CFP · image size 1534x1534: 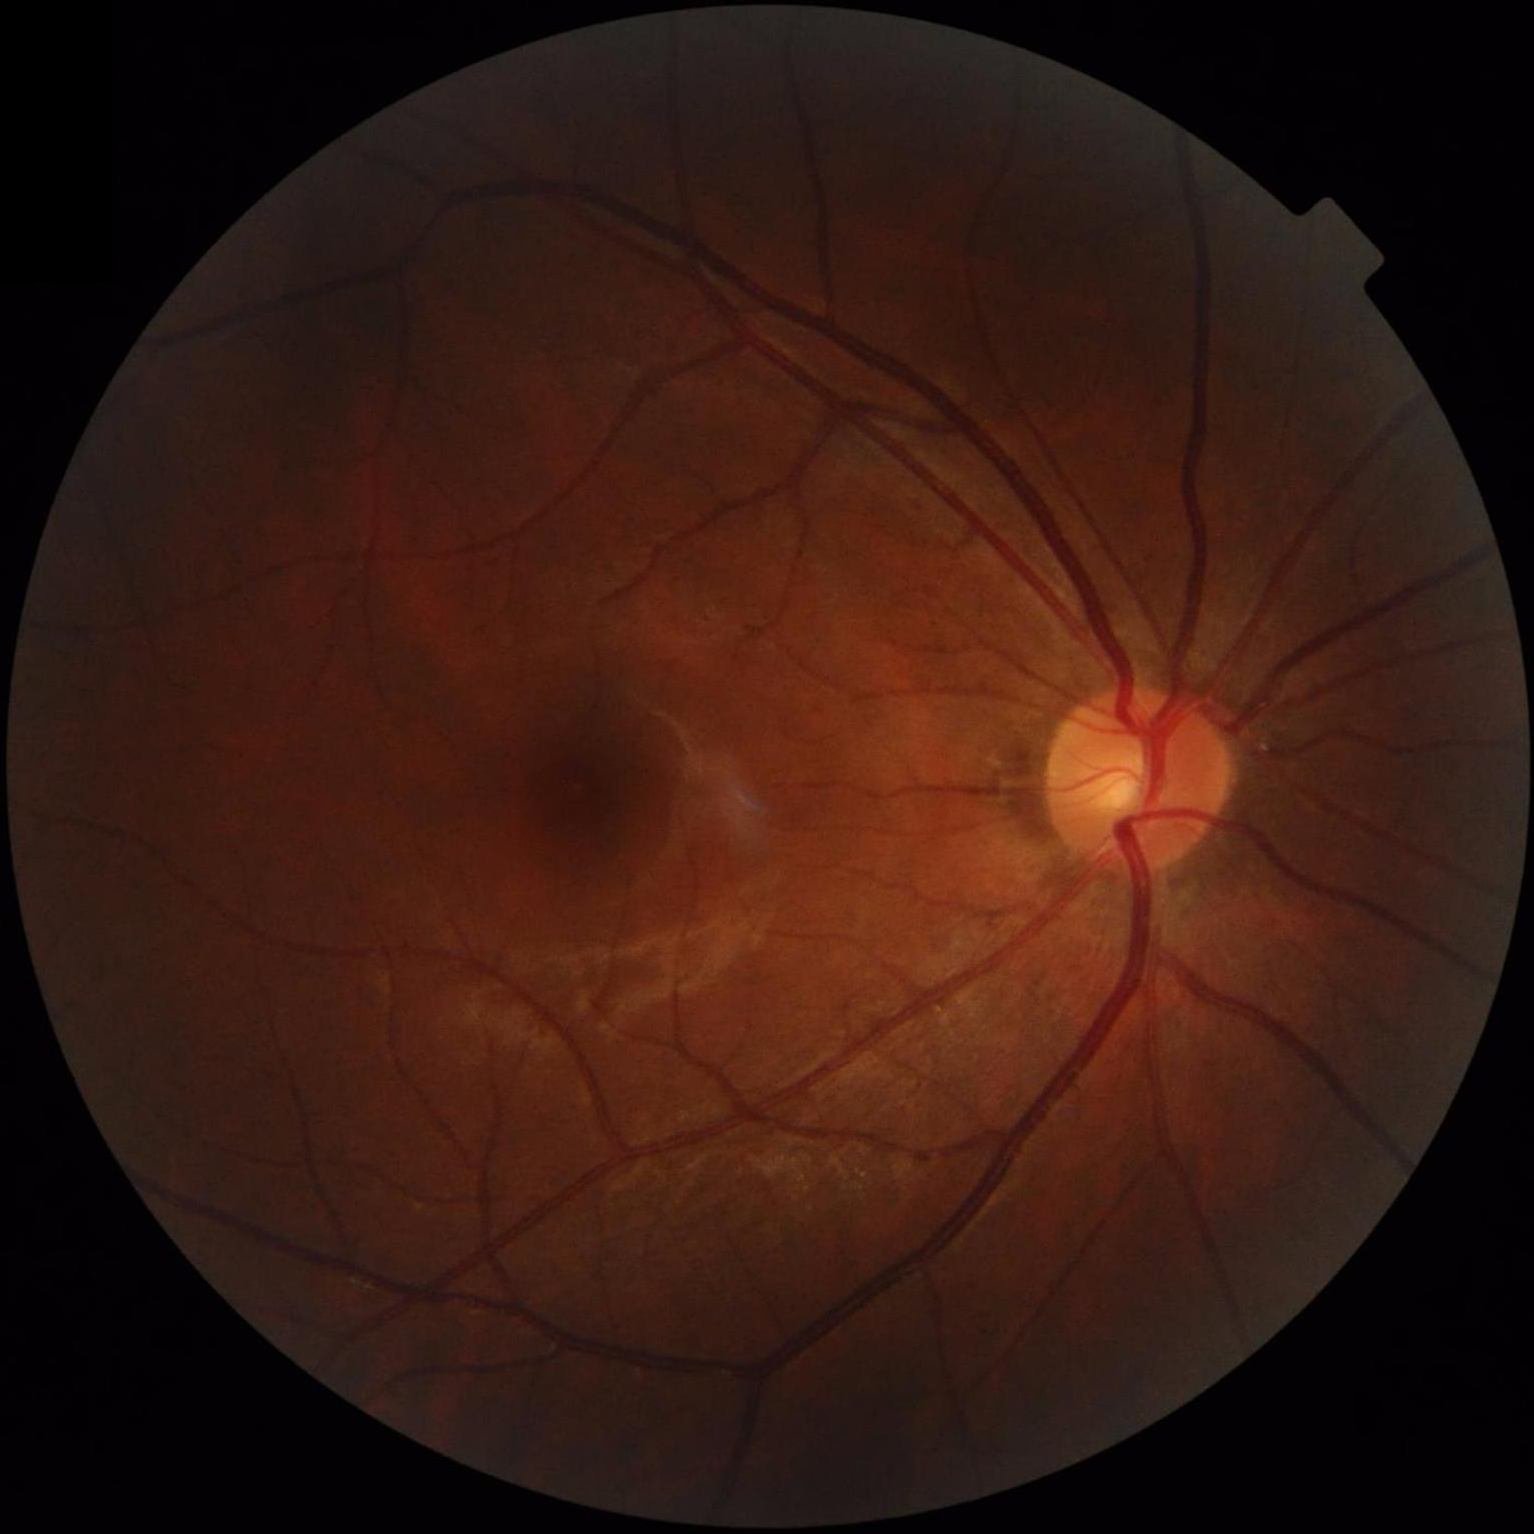
Good dynamic range. Illumination is uneven. Image quality is adequate for diagnostic use.